Axial length 22.55 mm; 63-year-old patient; pachymetry: 544 µm; autorefraction: sphere +2.5 D, cylinder -1 D, axis 77°.
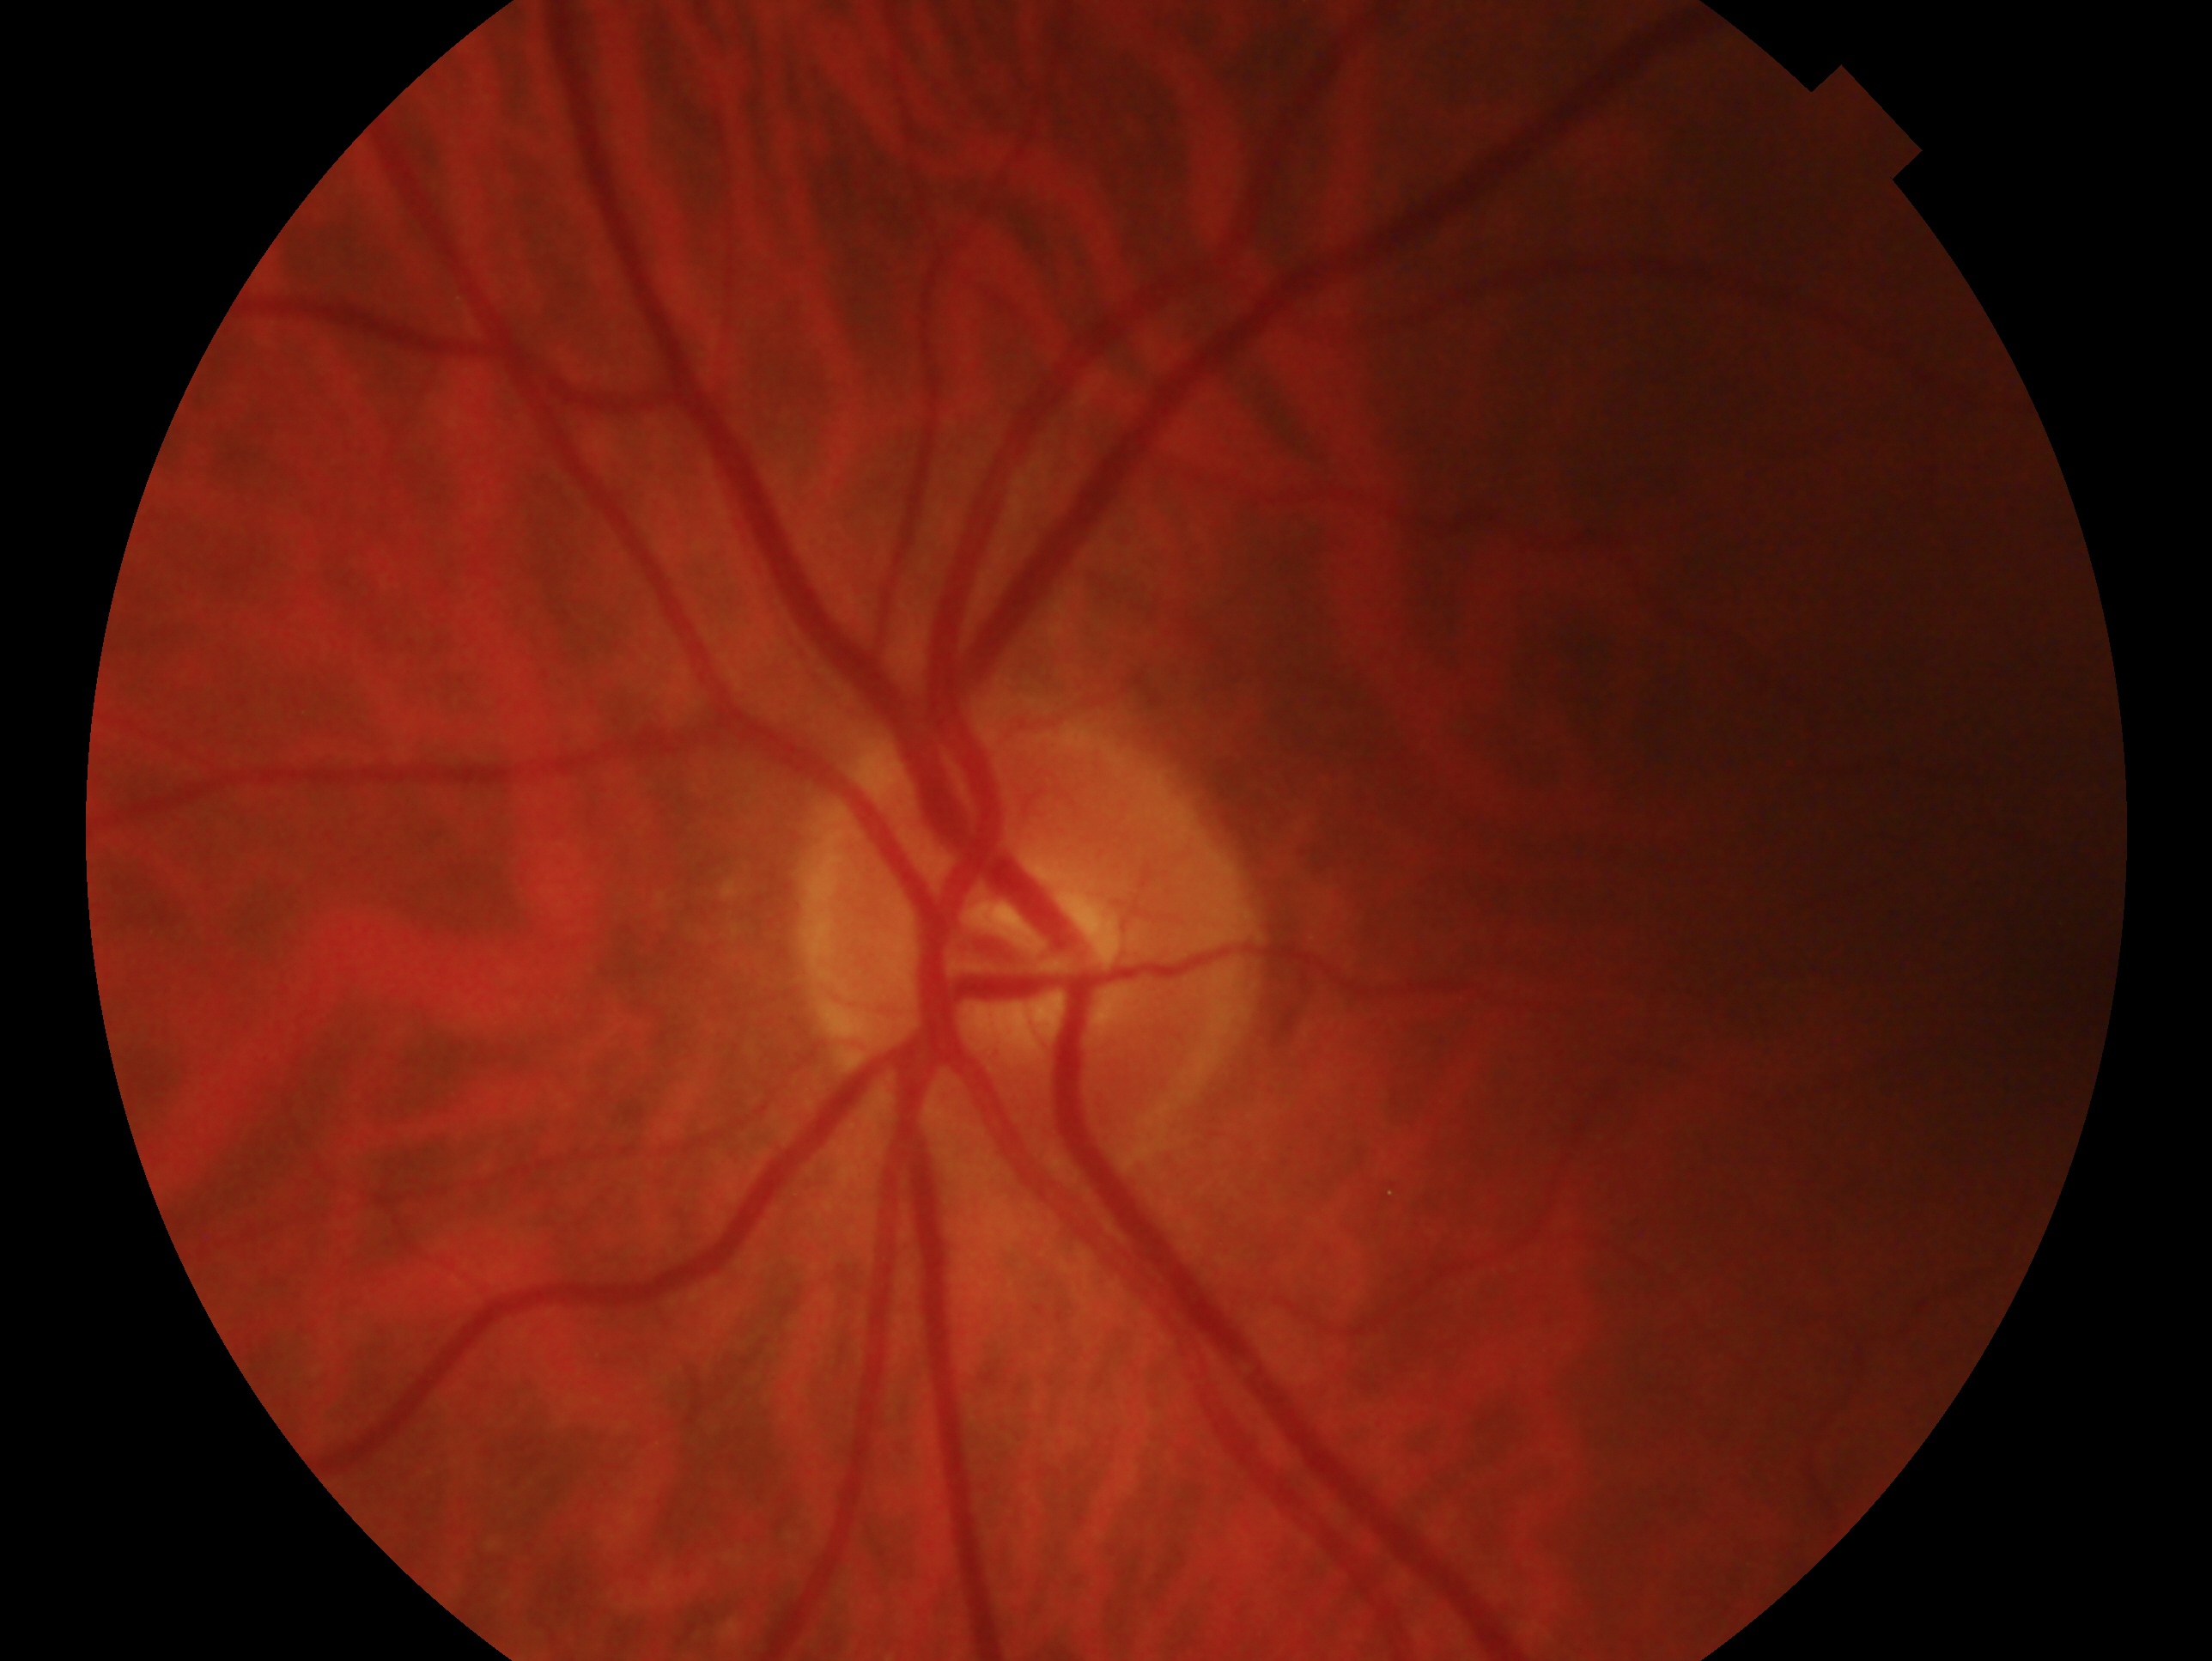

Clinical classification: no glaucomatous findings — no clinical evidence of glaucoma in this eye.
This is the oculus sinister.